Wide-field fundus photograph of an infant.
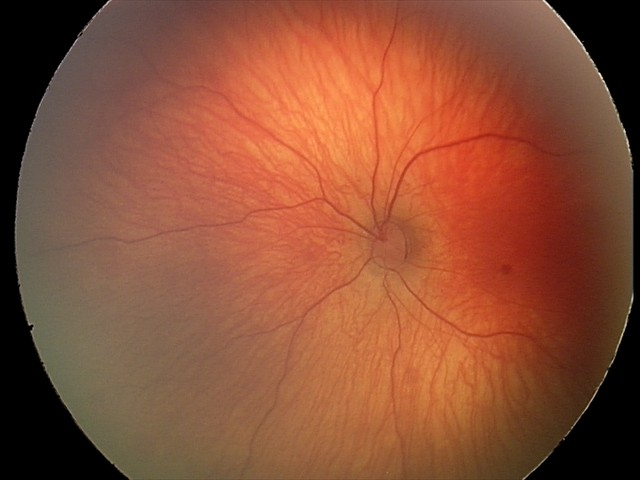

From an examination with diagnosis of retinal hemorrhages.